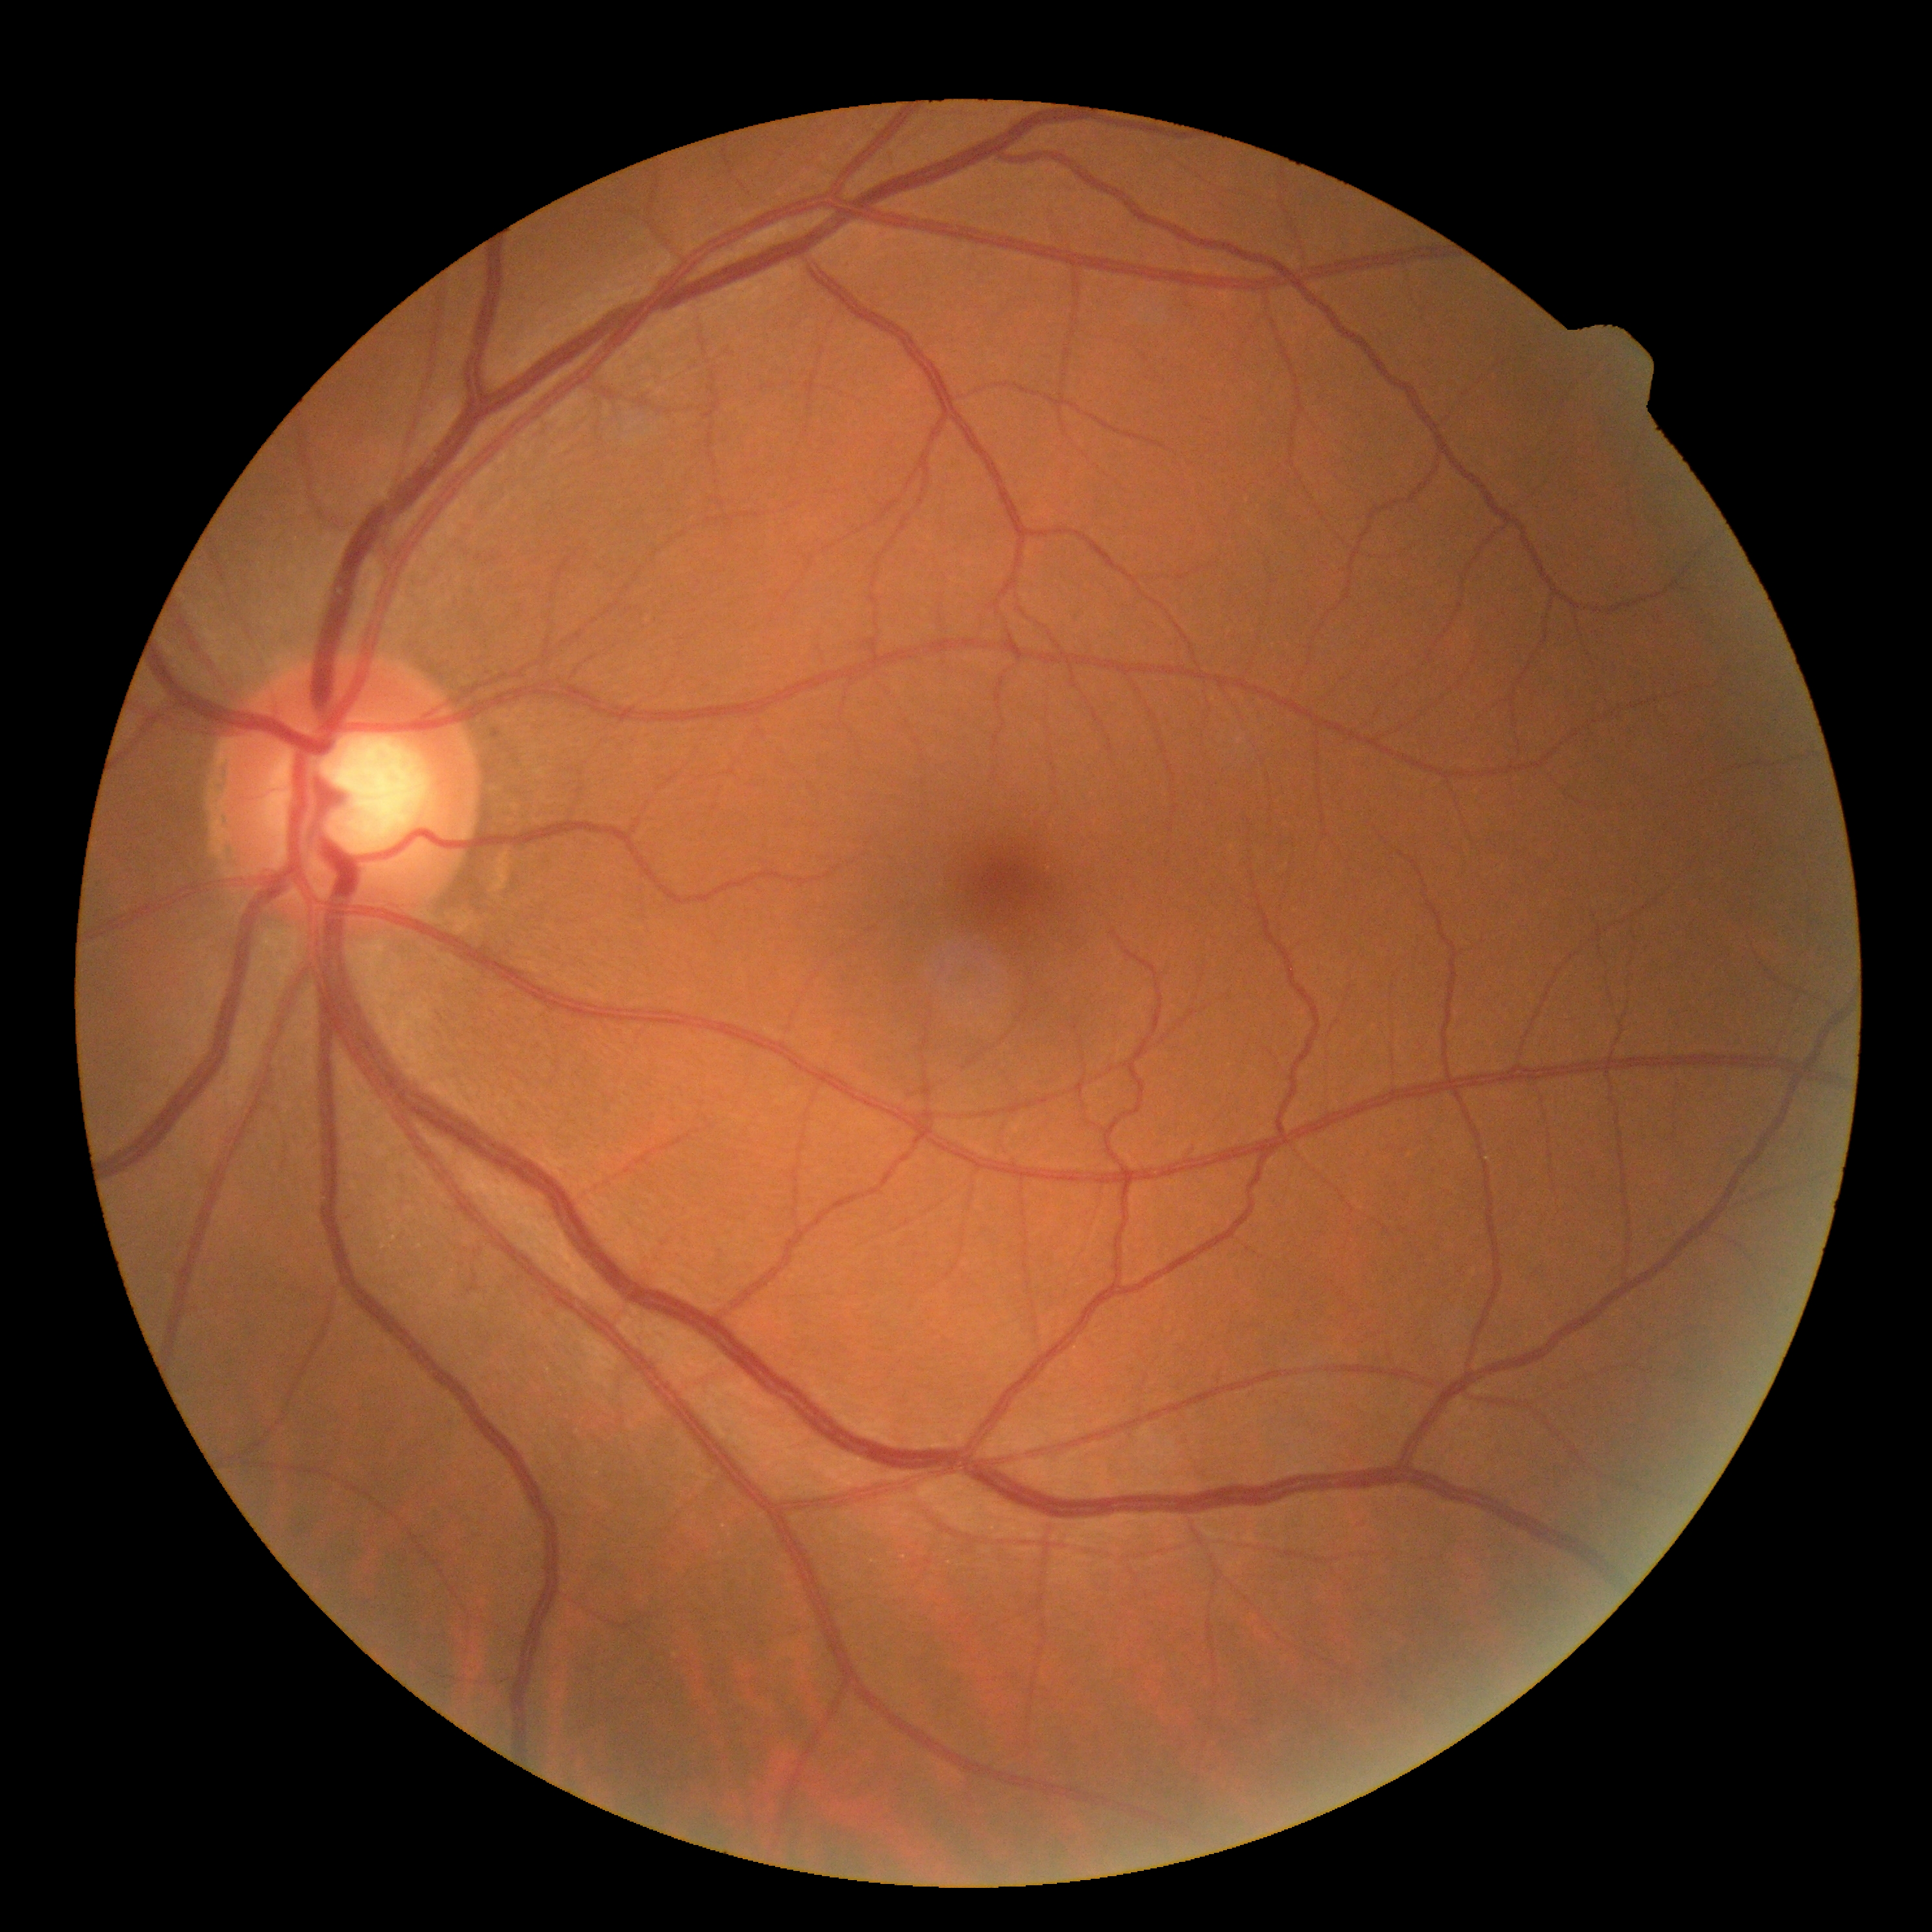
Diabetic retinopathy (DR): 0.